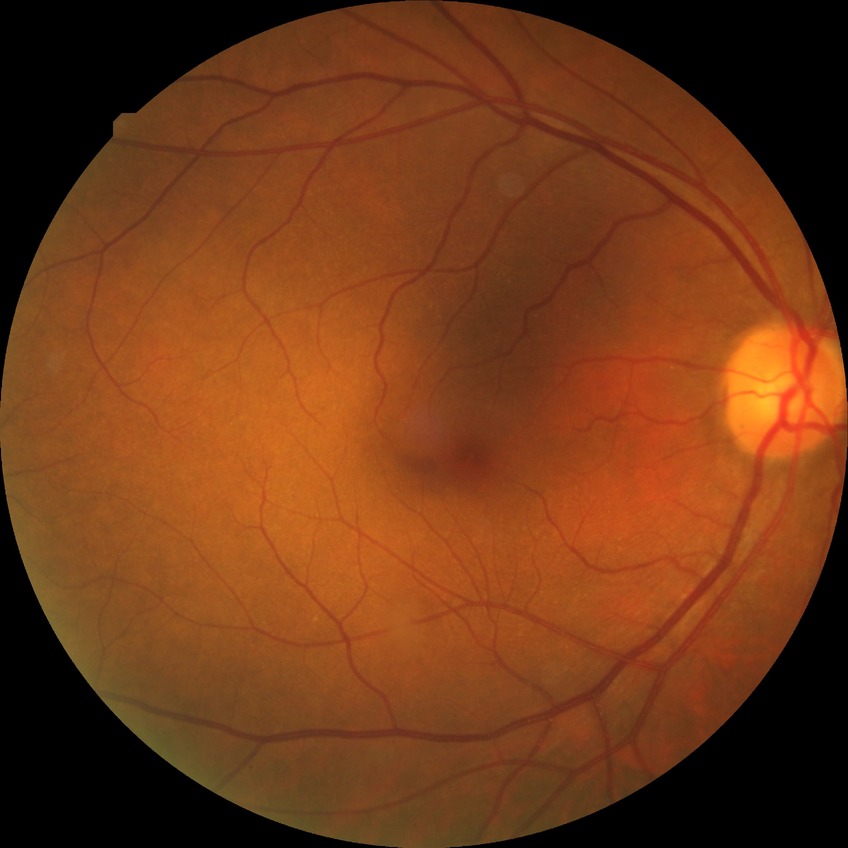
Diabetic retinopathy (DR): NDR (no diabetic retinopathy).